2212 x 1659 pixels:
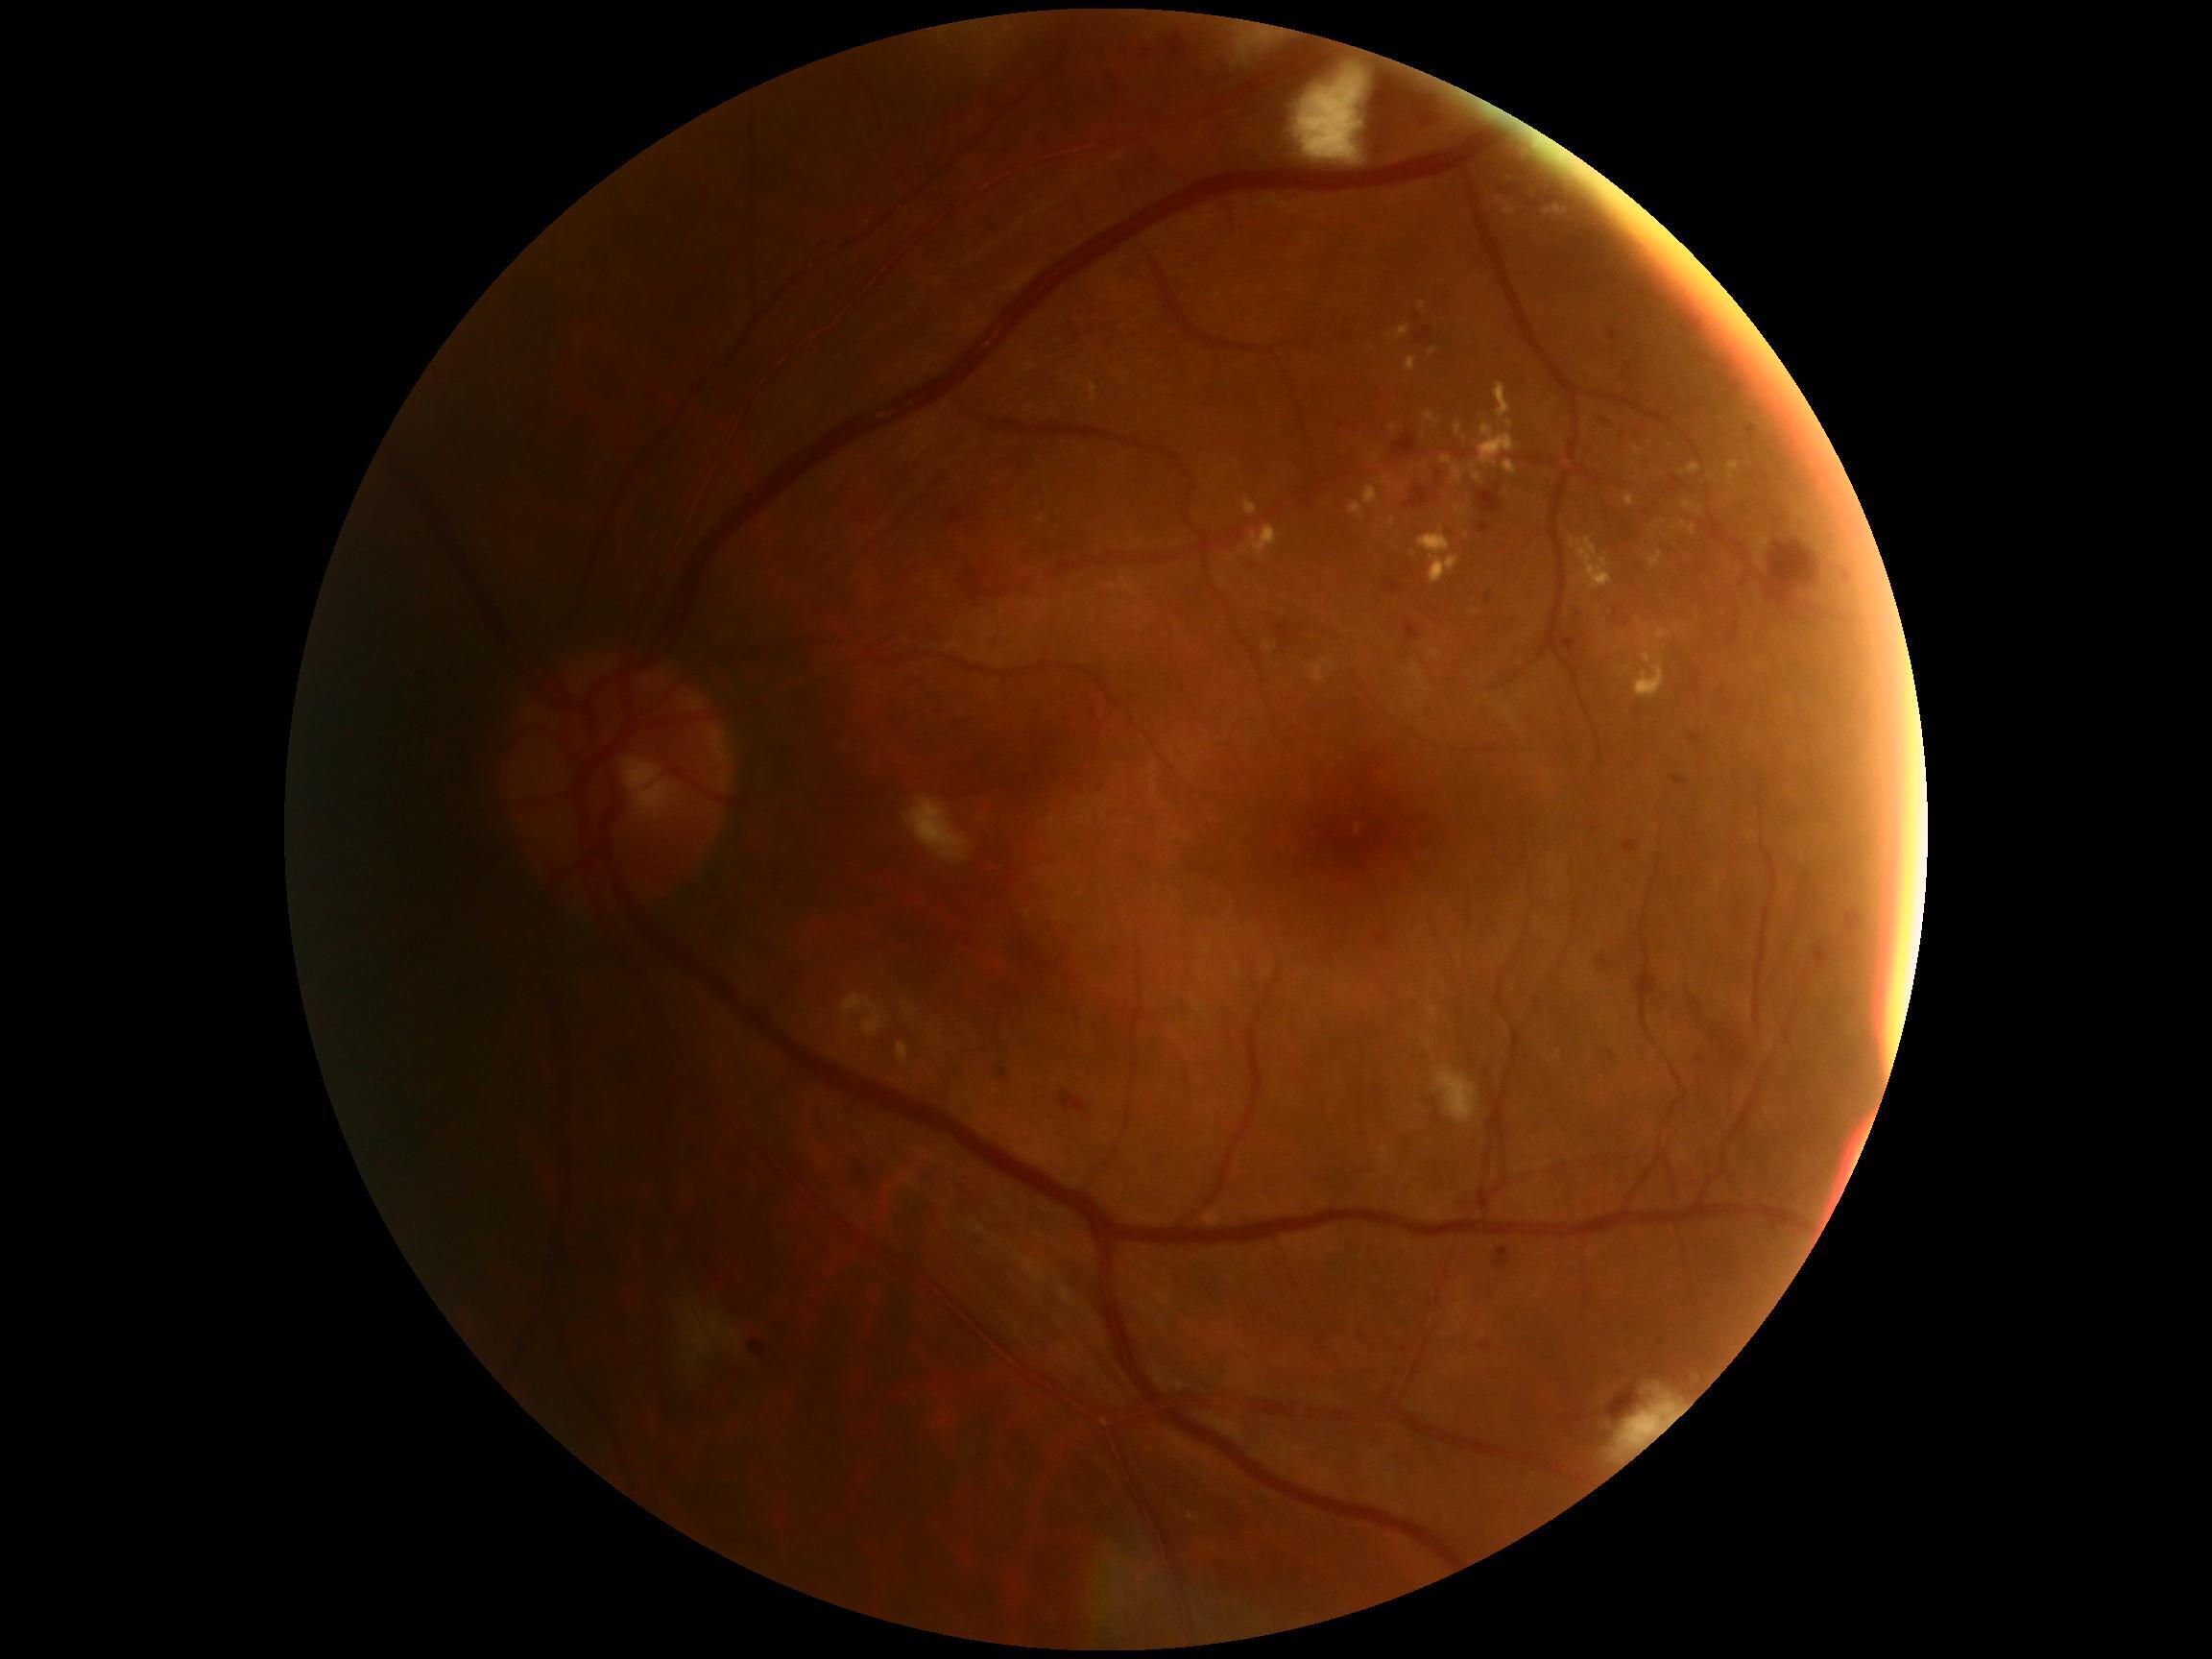
DR grade is moderate non-proliferative diabetic retinopathy (2).